45° field of view. 2352x1568. Color fundus image — 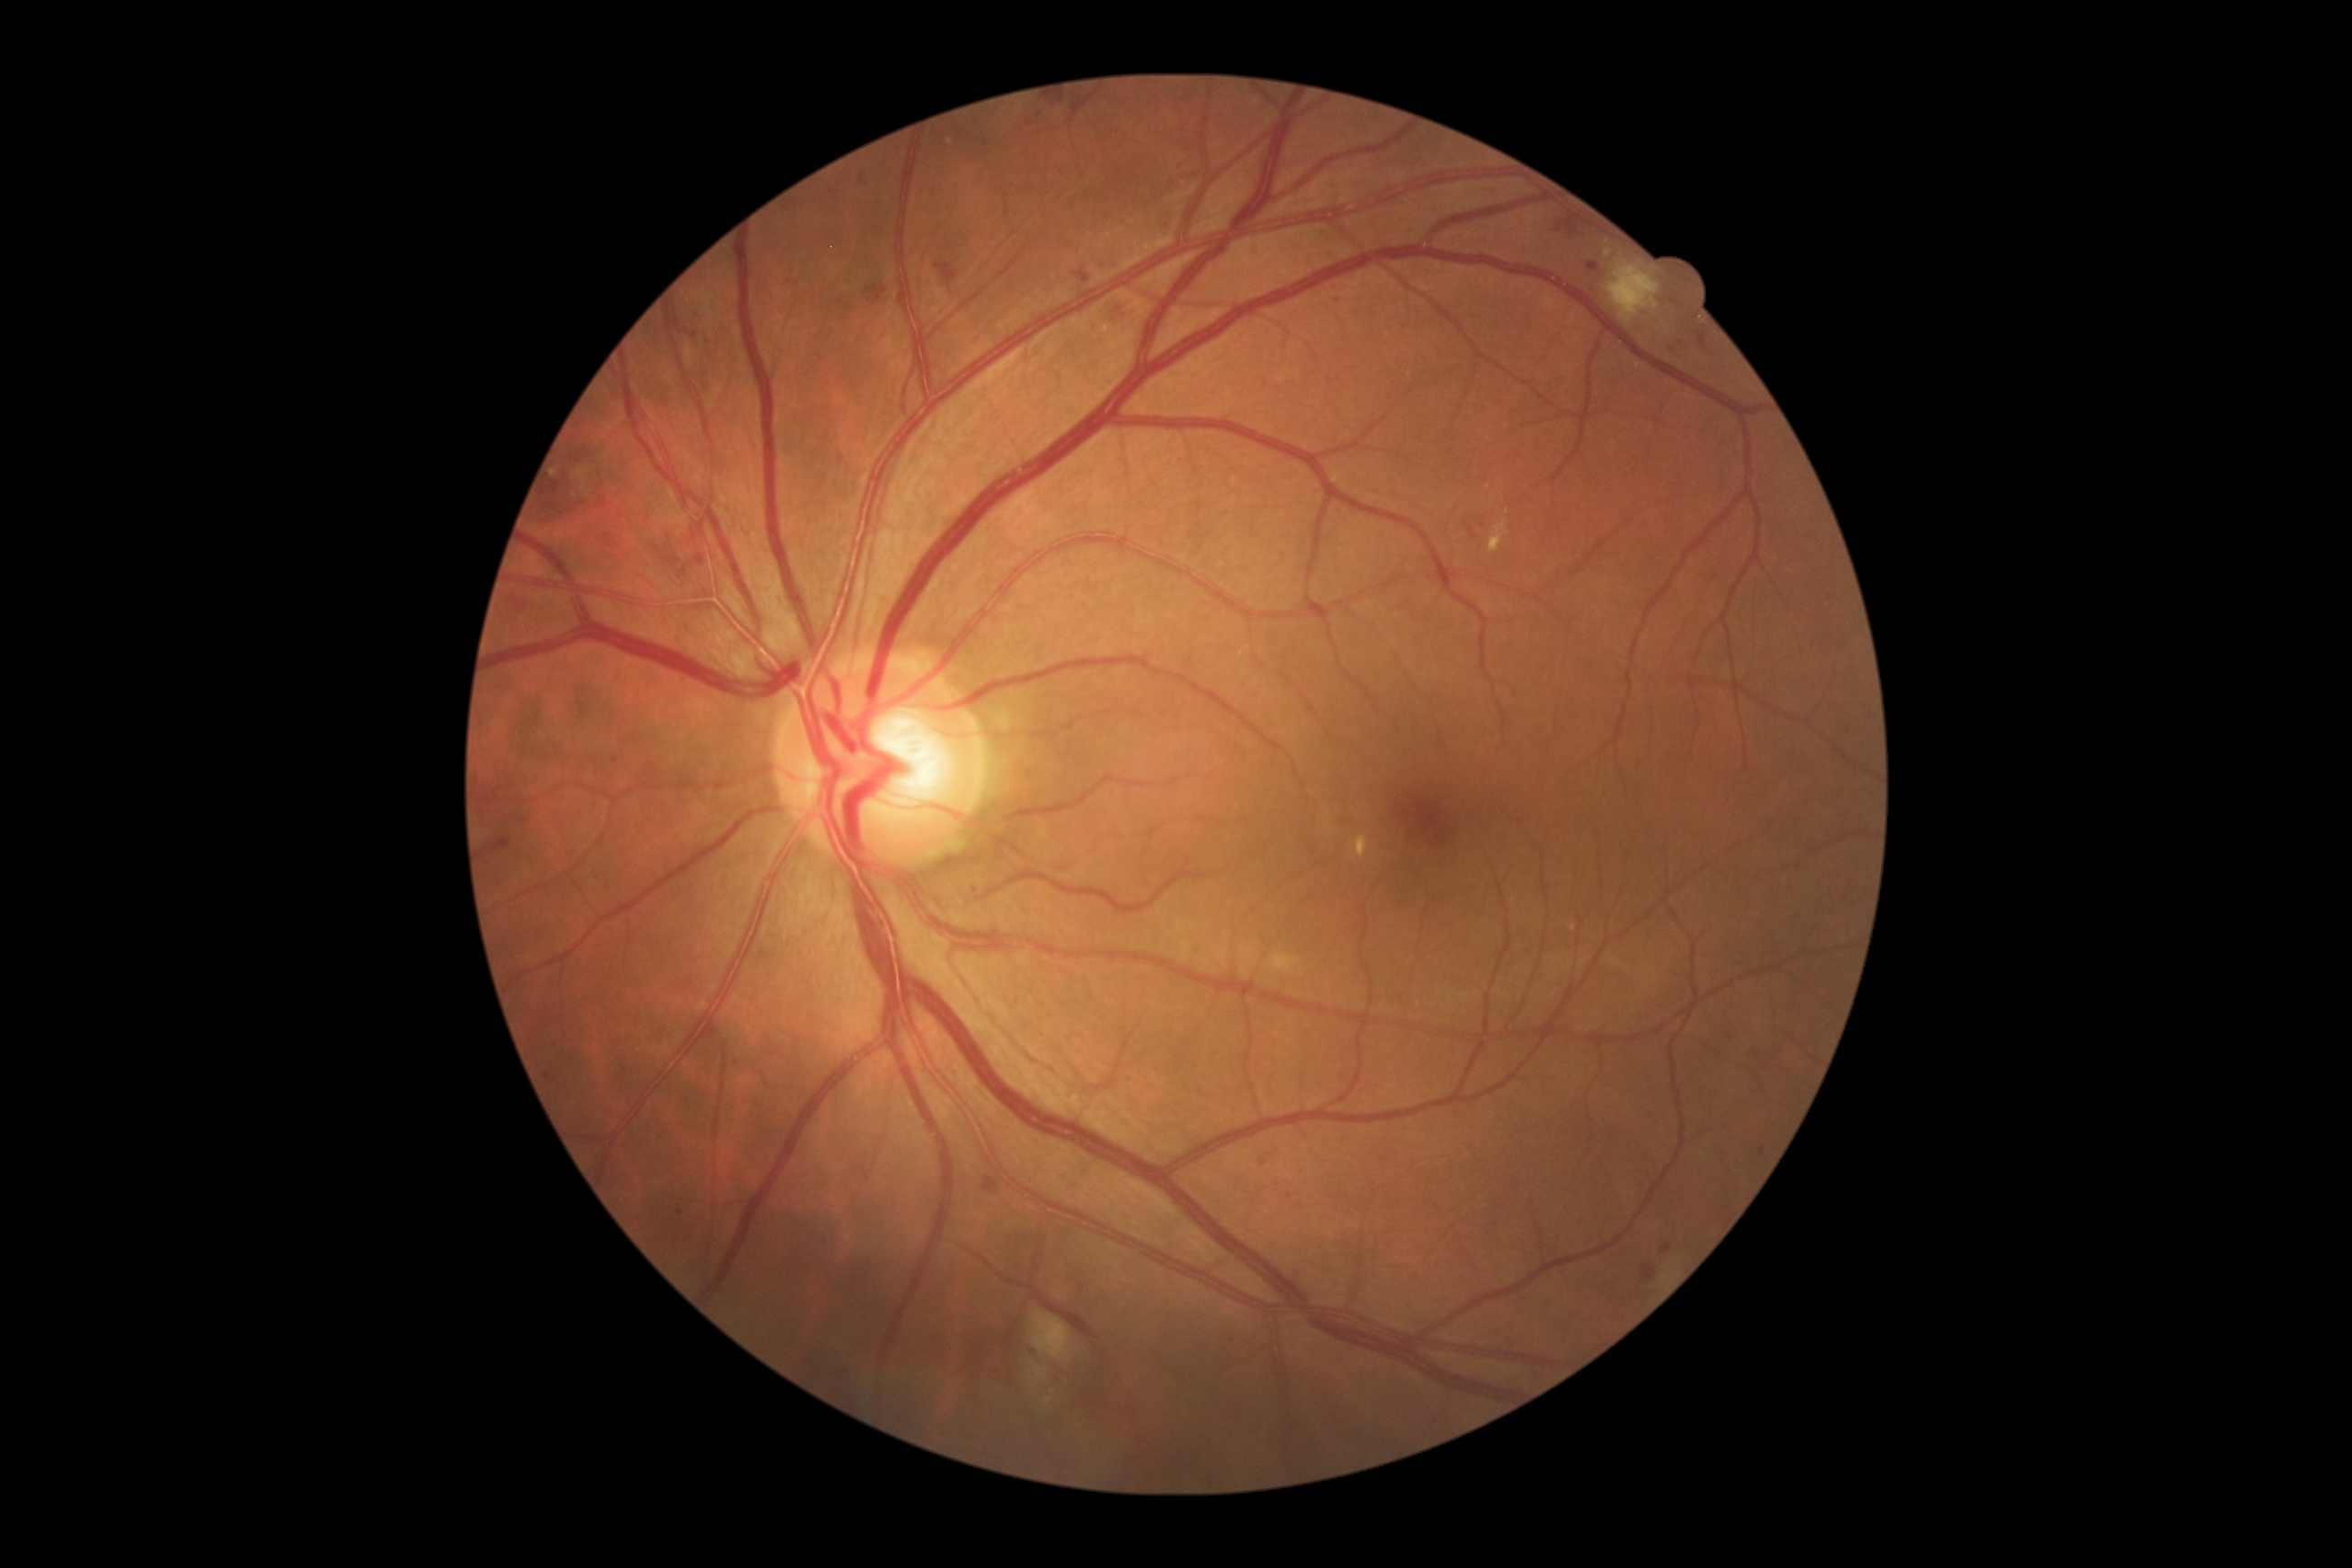 Diabetic retinopathy grade is 2 (moderate NPDR). Microaneurysms include lesions at 1759,1148,1767,1157 | 1465,522,1476,540 | 1696,331,1710,353 | 1587,262,1600,273 | 1250,244,1259,253 | 1179,173,1193,184 | 696,554,705,565 | 545,1073,554,1083 | 1338,295,1344,304 | 983,1177,1003,1195 | 1642,1264,1658,1284 | 934,264,957,286. Smaller microaneurysms around (x=1730, y=1039) | (x=482, y=813) | (x=695, y=335) | (x=680, y=1213) | (x=1672, y=350) | (x=1264, y=1164). Soft exudates include lesions at 1030,1311,1075,1364 | 1046,1398,1052,1406 | 1271,952,1300,974 | 1032,1364,1046,1382 | 1605,260,1661,324. Hard exudates present at 1489,522,1509,553 | 1351,834,1369,859. Smaller hard exudates around (x=1608, y=253) | (x=1507, y=512) | (x=1608, y=241) | (x=556, y=474) | (x=1489, y=488). Hemorrhages include lesions at 1166,208,1177,235 | 1104,299,1137,328 | 1558,211,1587,235.